Retinal fundus photograph
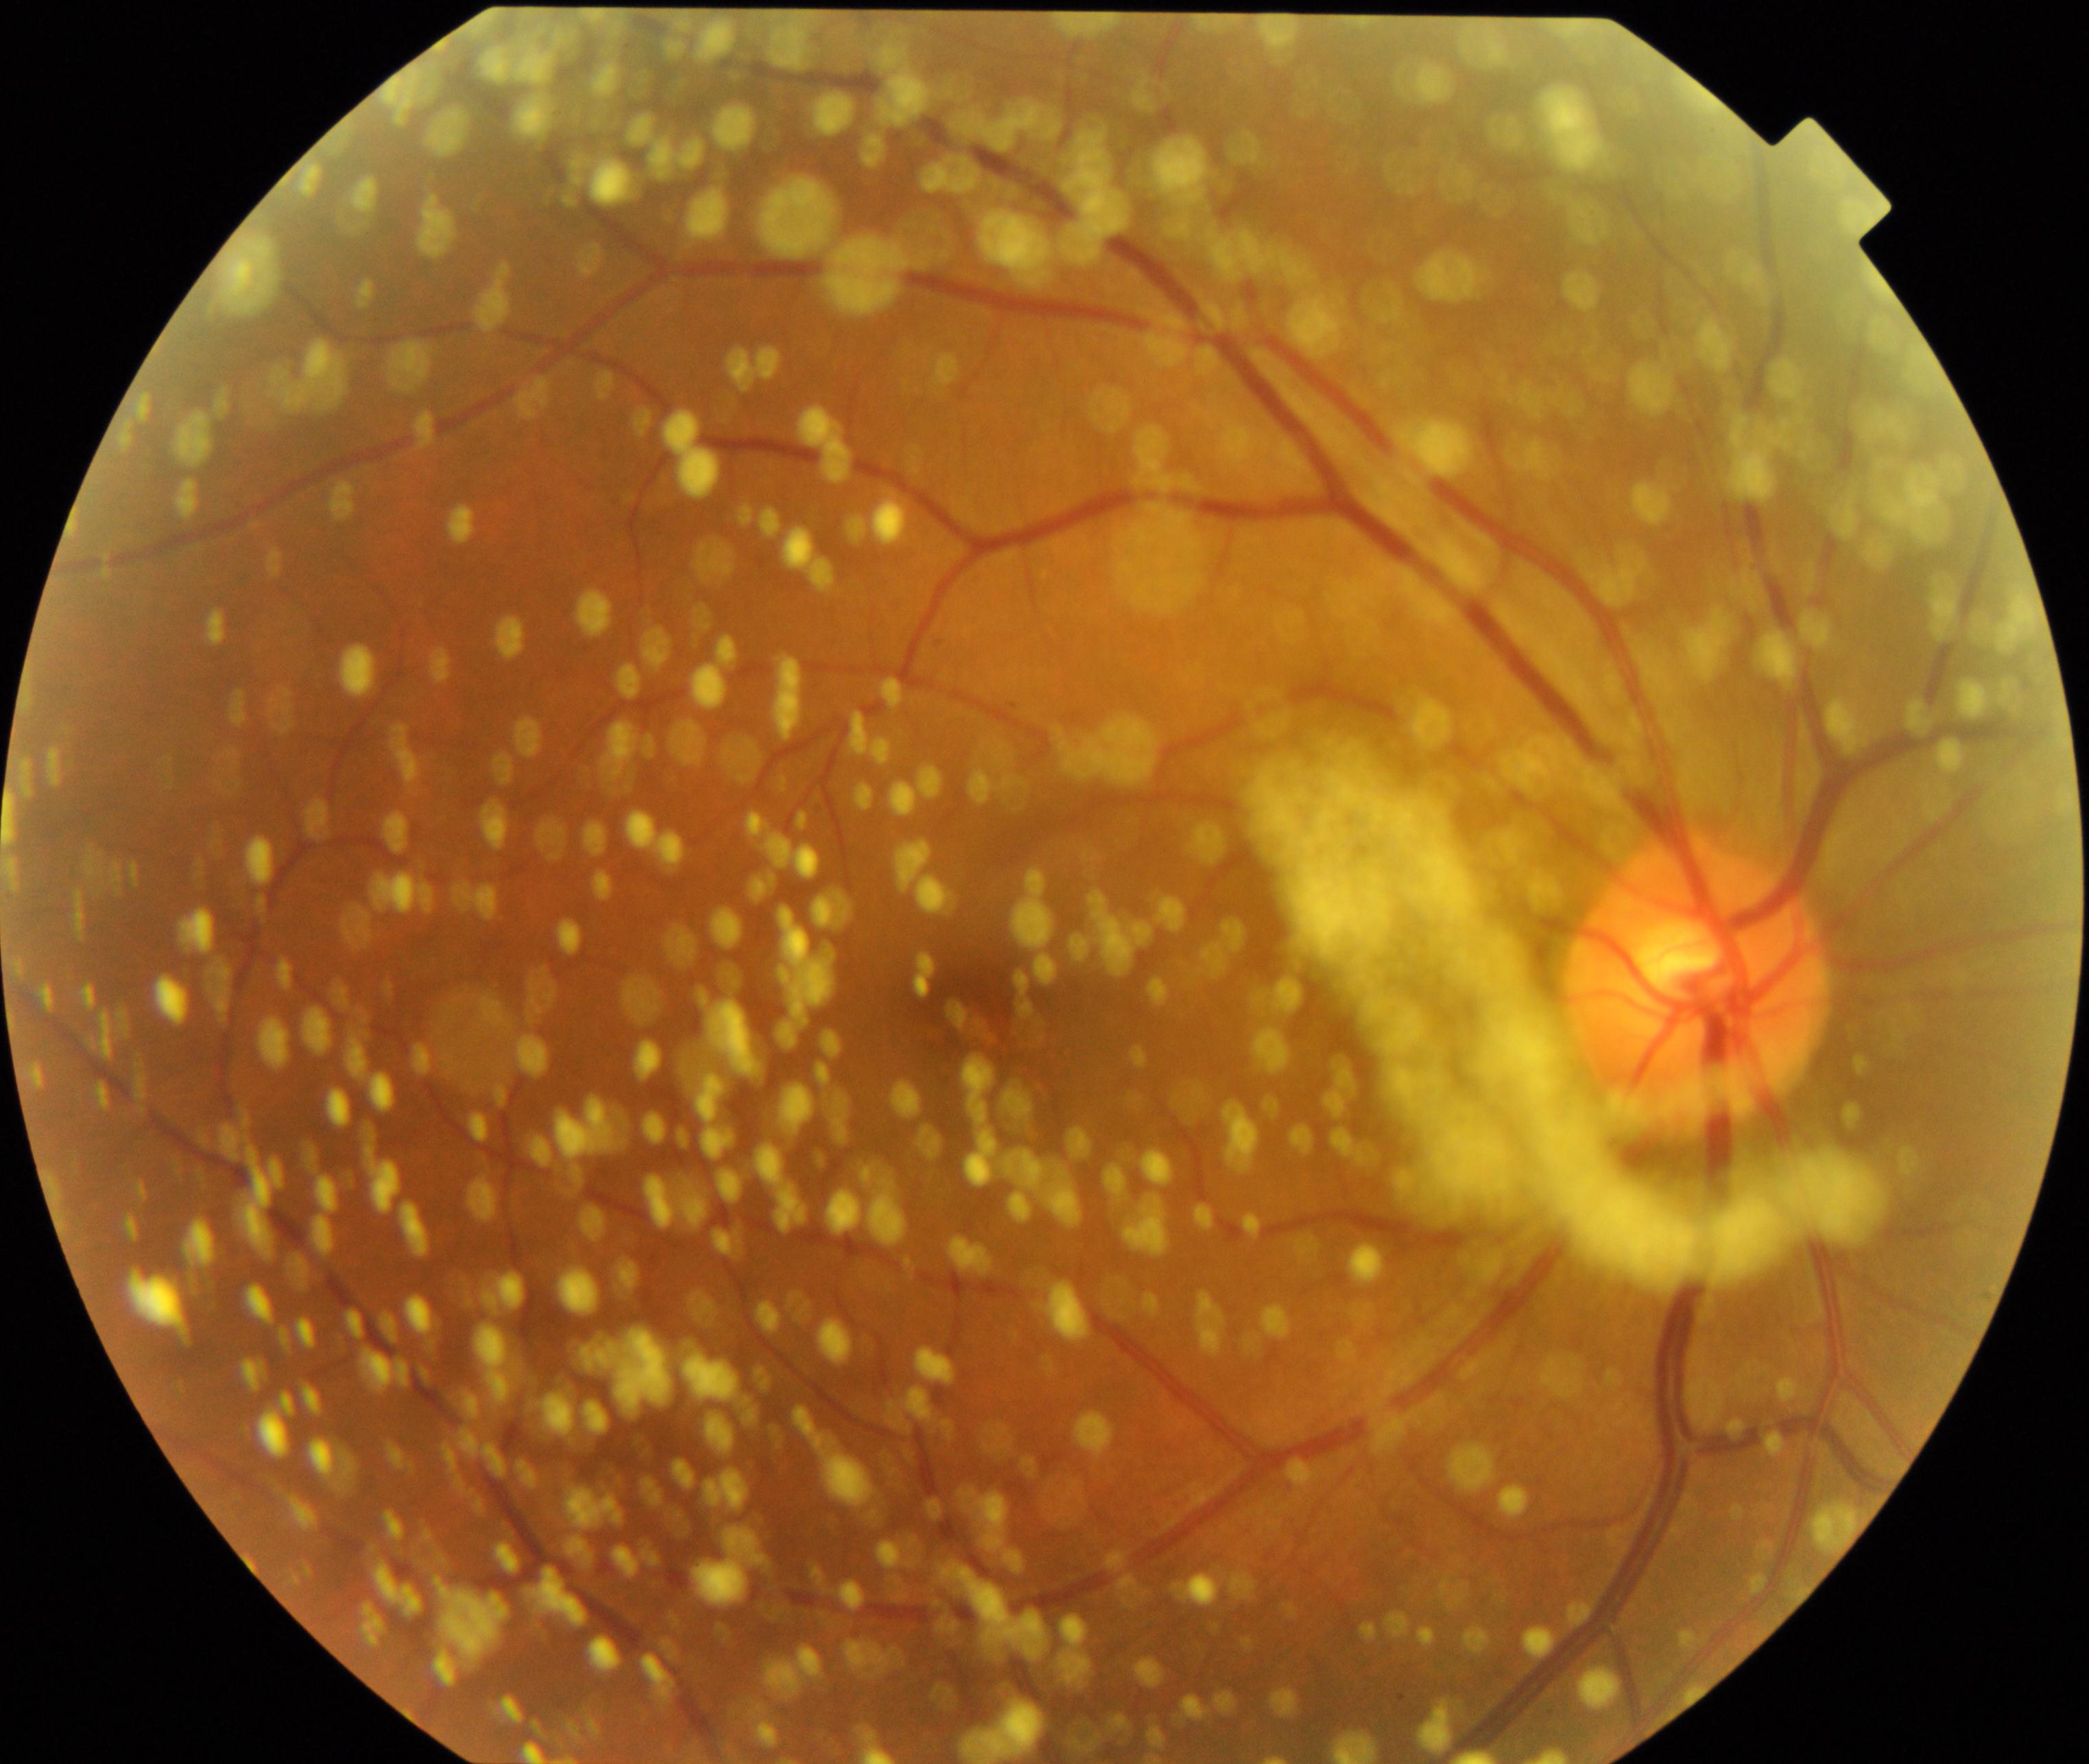 Findings: vitreous particles. Defined by vitreous opacities including asteroid hyalosis, synchysis scintillans, and deposits of familial amyloidosis.